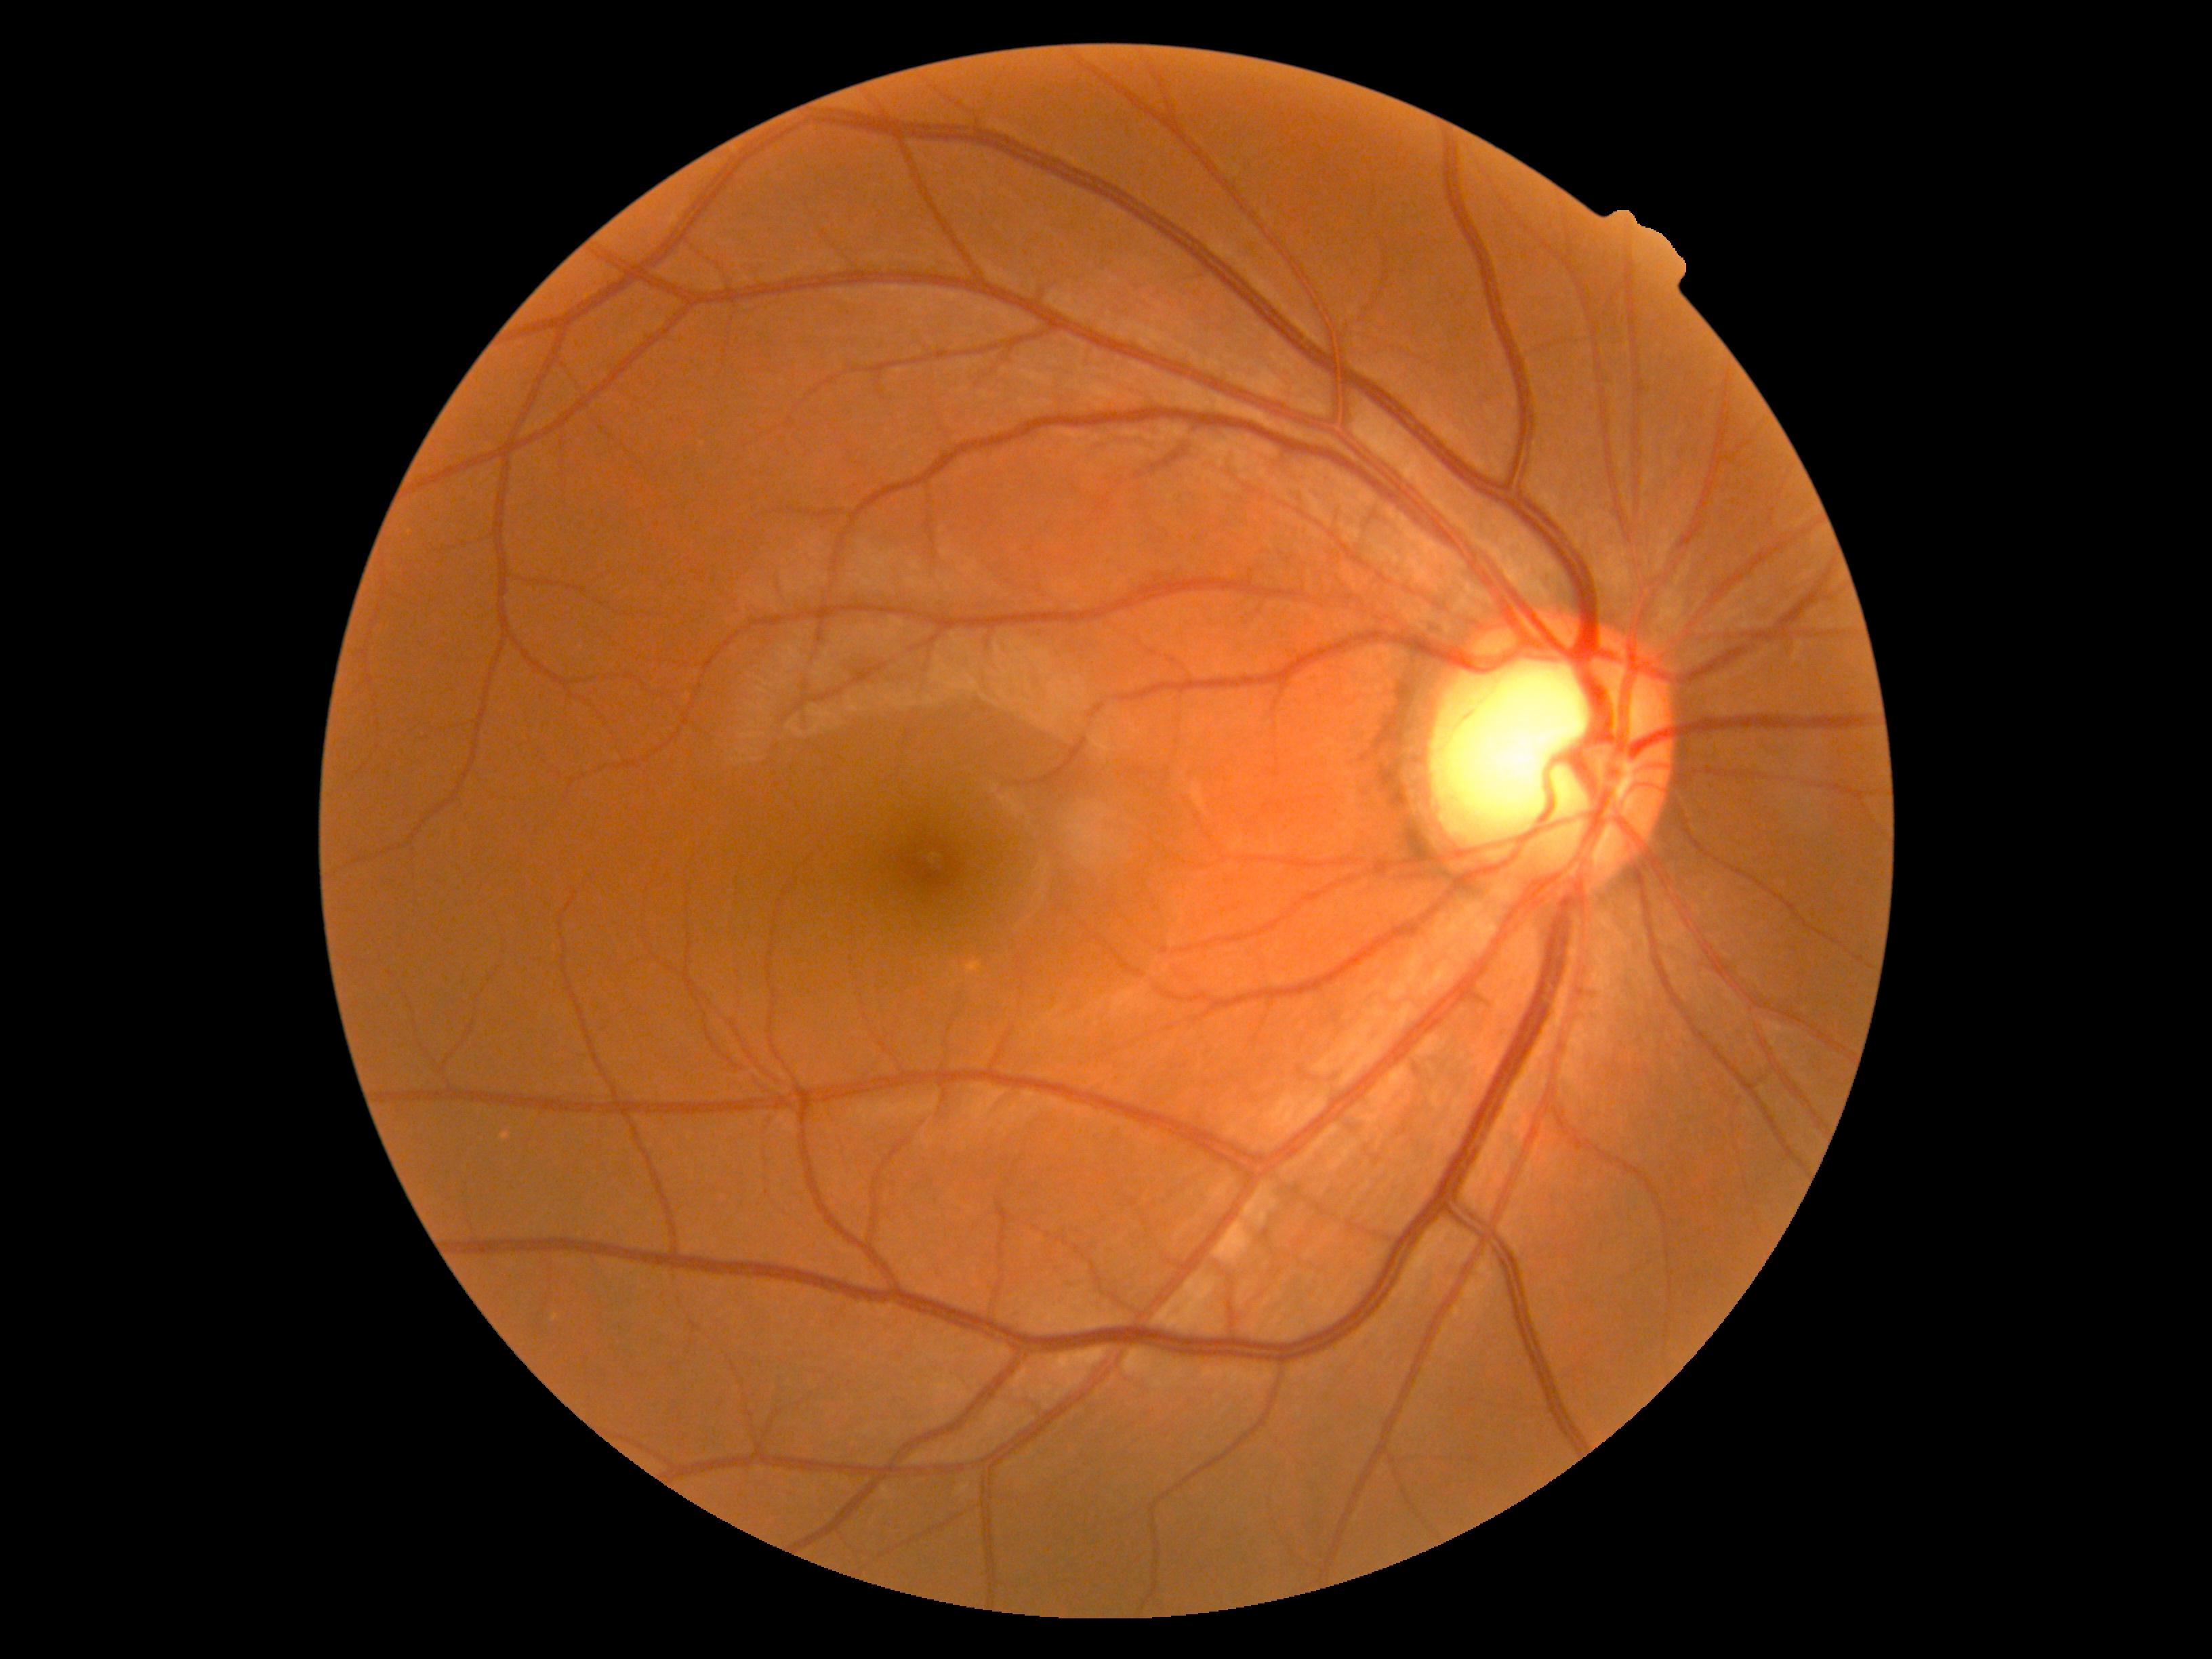 DR stage: grade 0 (no apparent retinopathy).